2352 x 1568 pixels
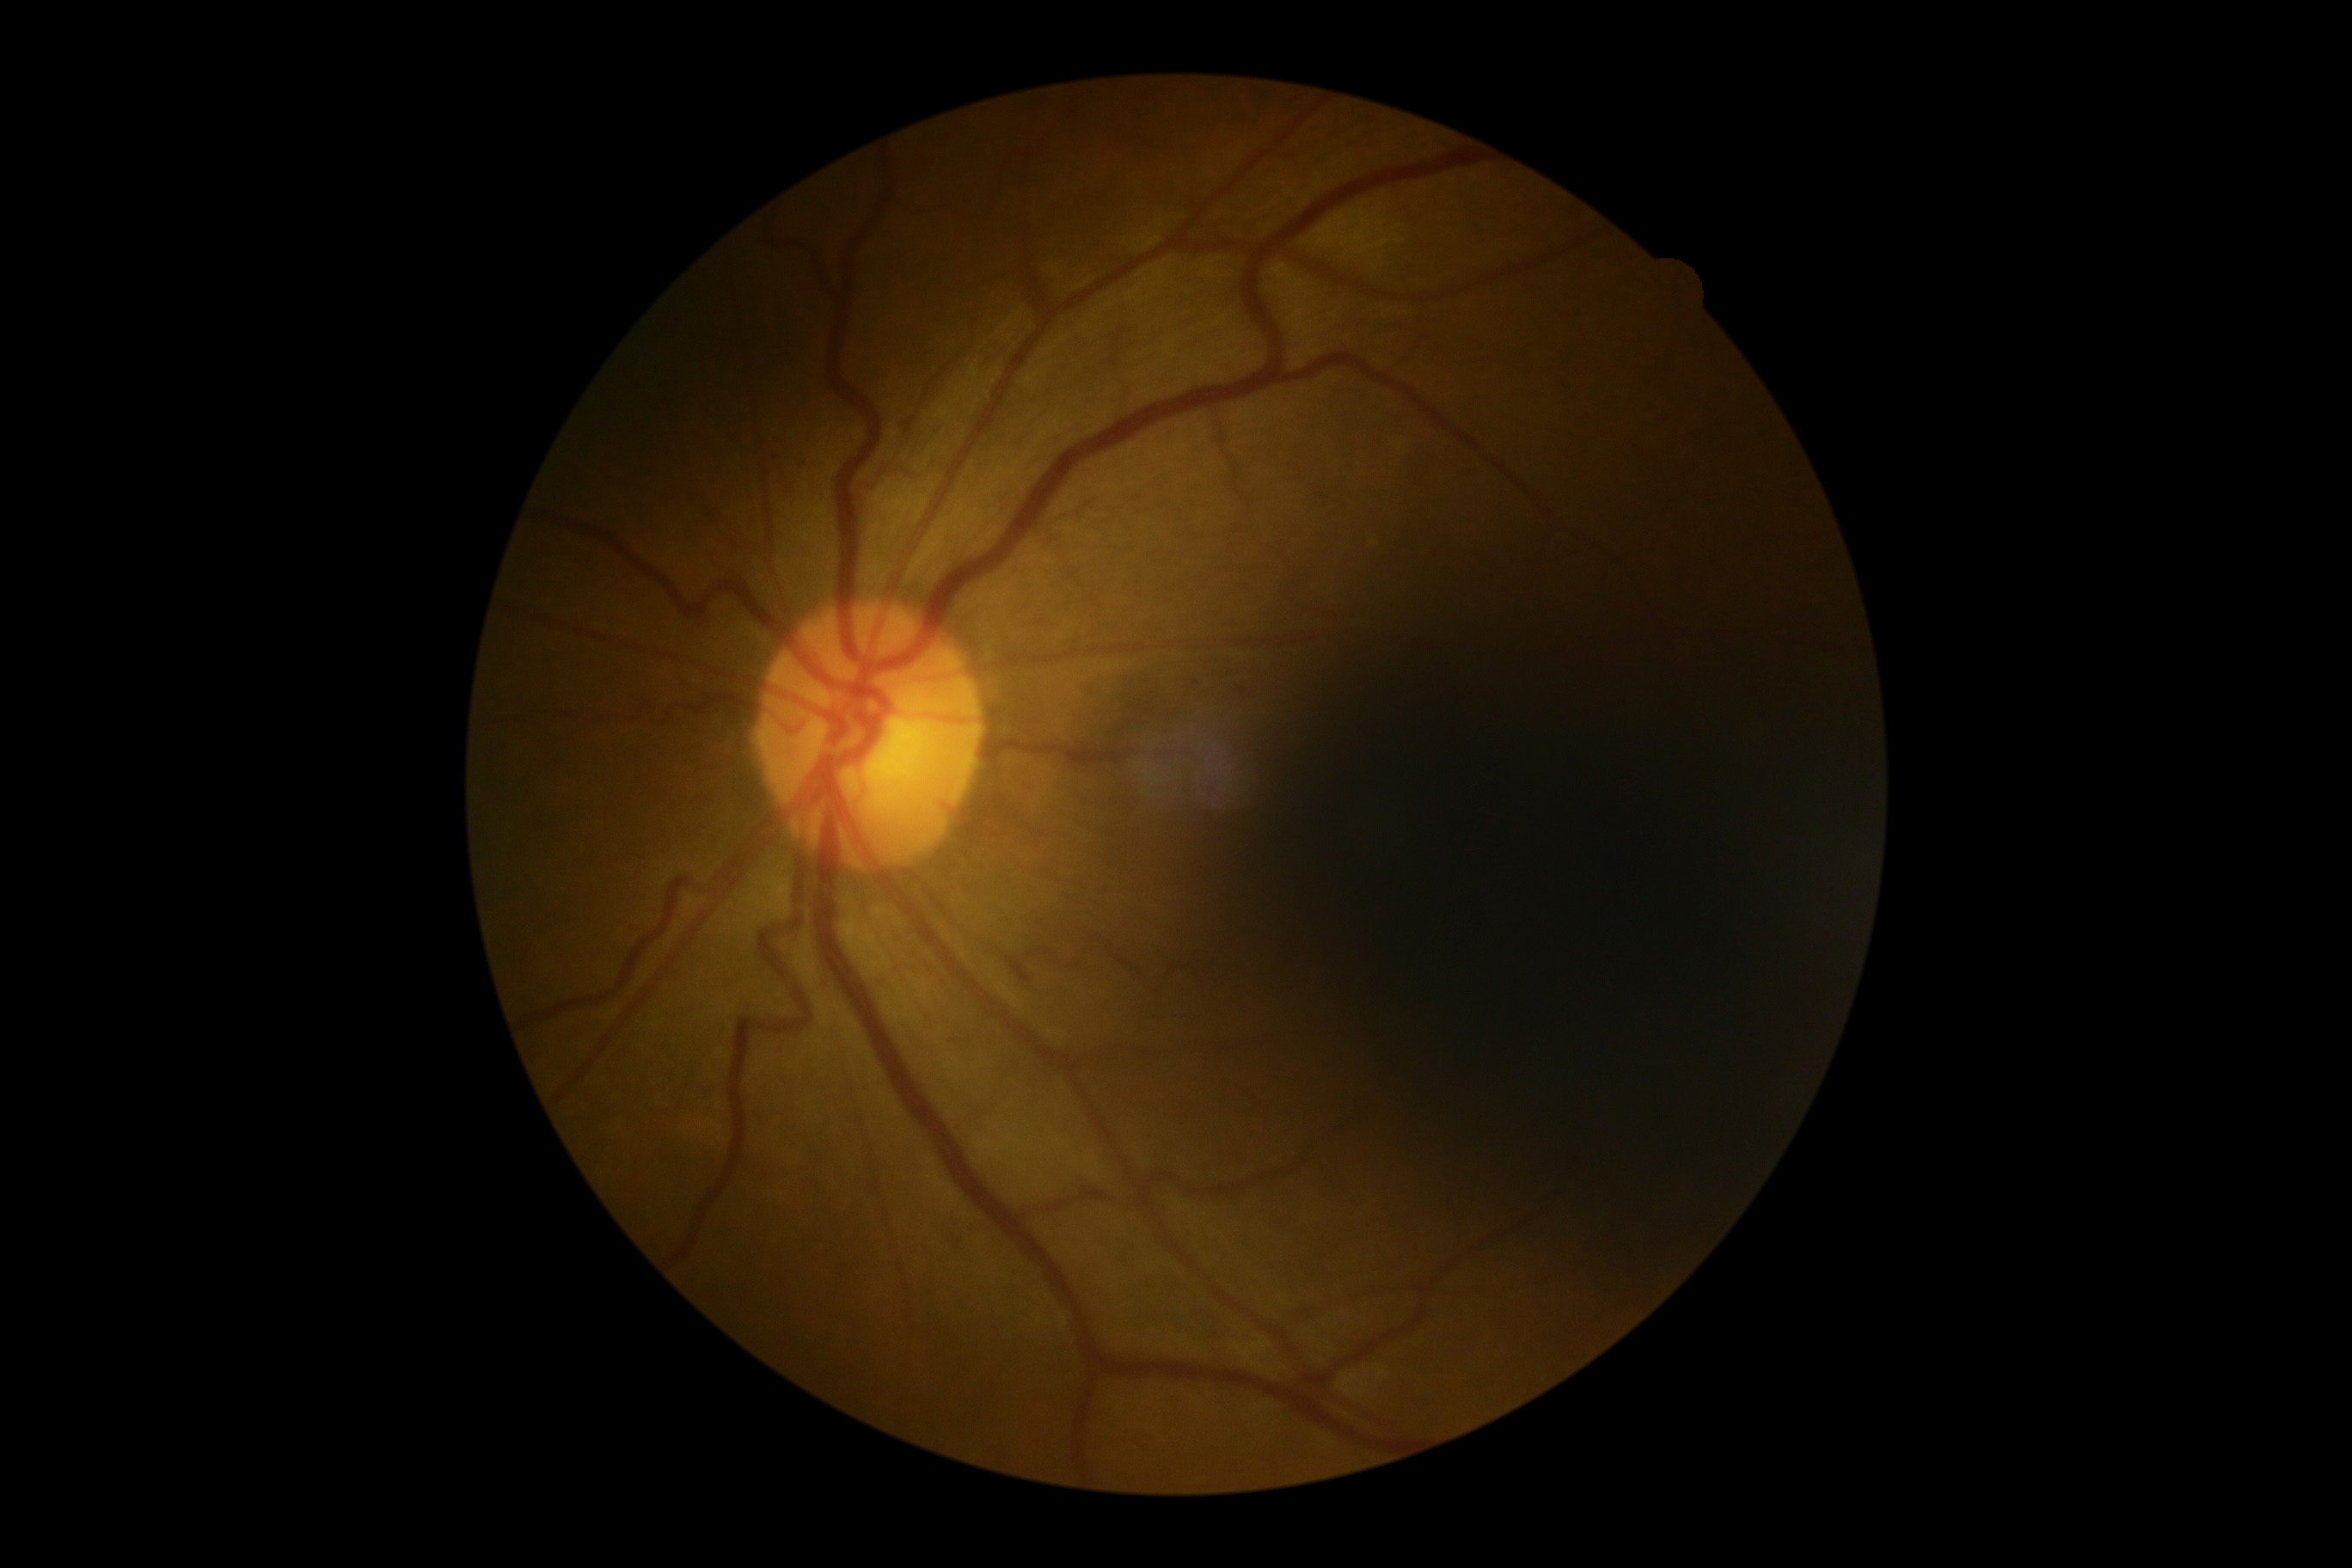
No signs of diabetic retinopathy. Retinopathy grade is no apparent retinopathy (0).